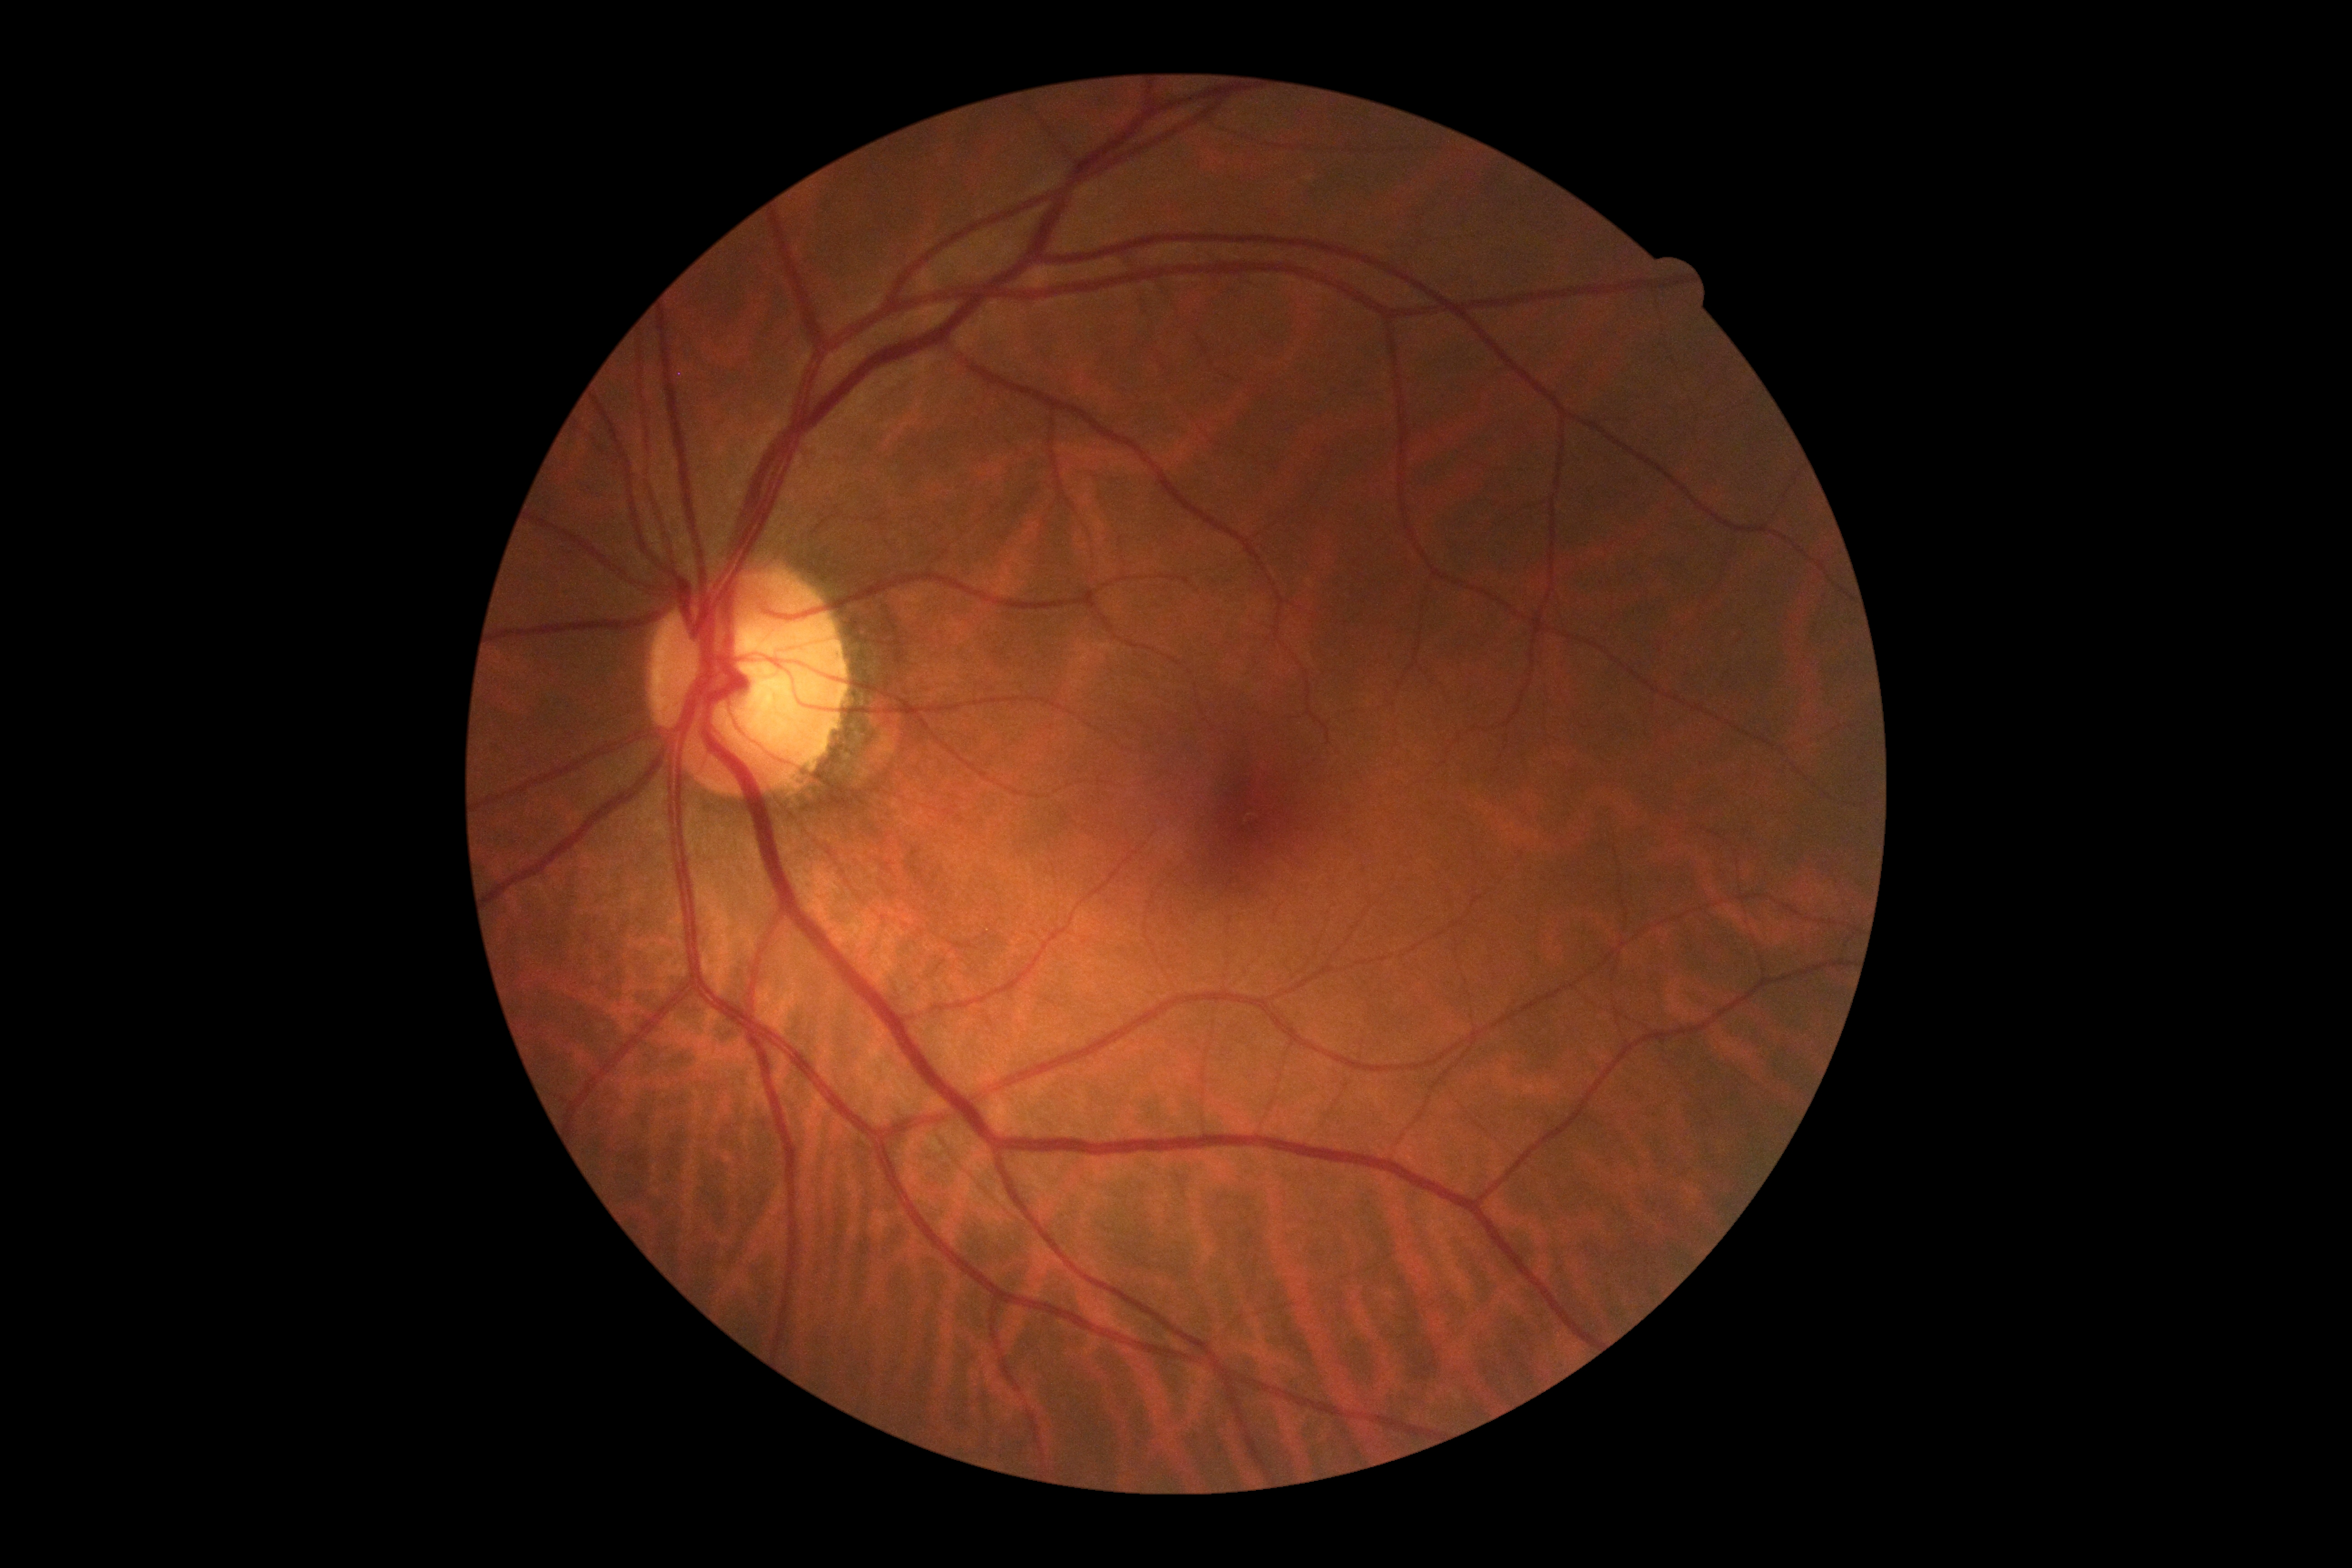
dr_impression: no signs of DR
dr_grade: 0 (no apparent retinopathy) — no visible signs of diabetic retinopathy